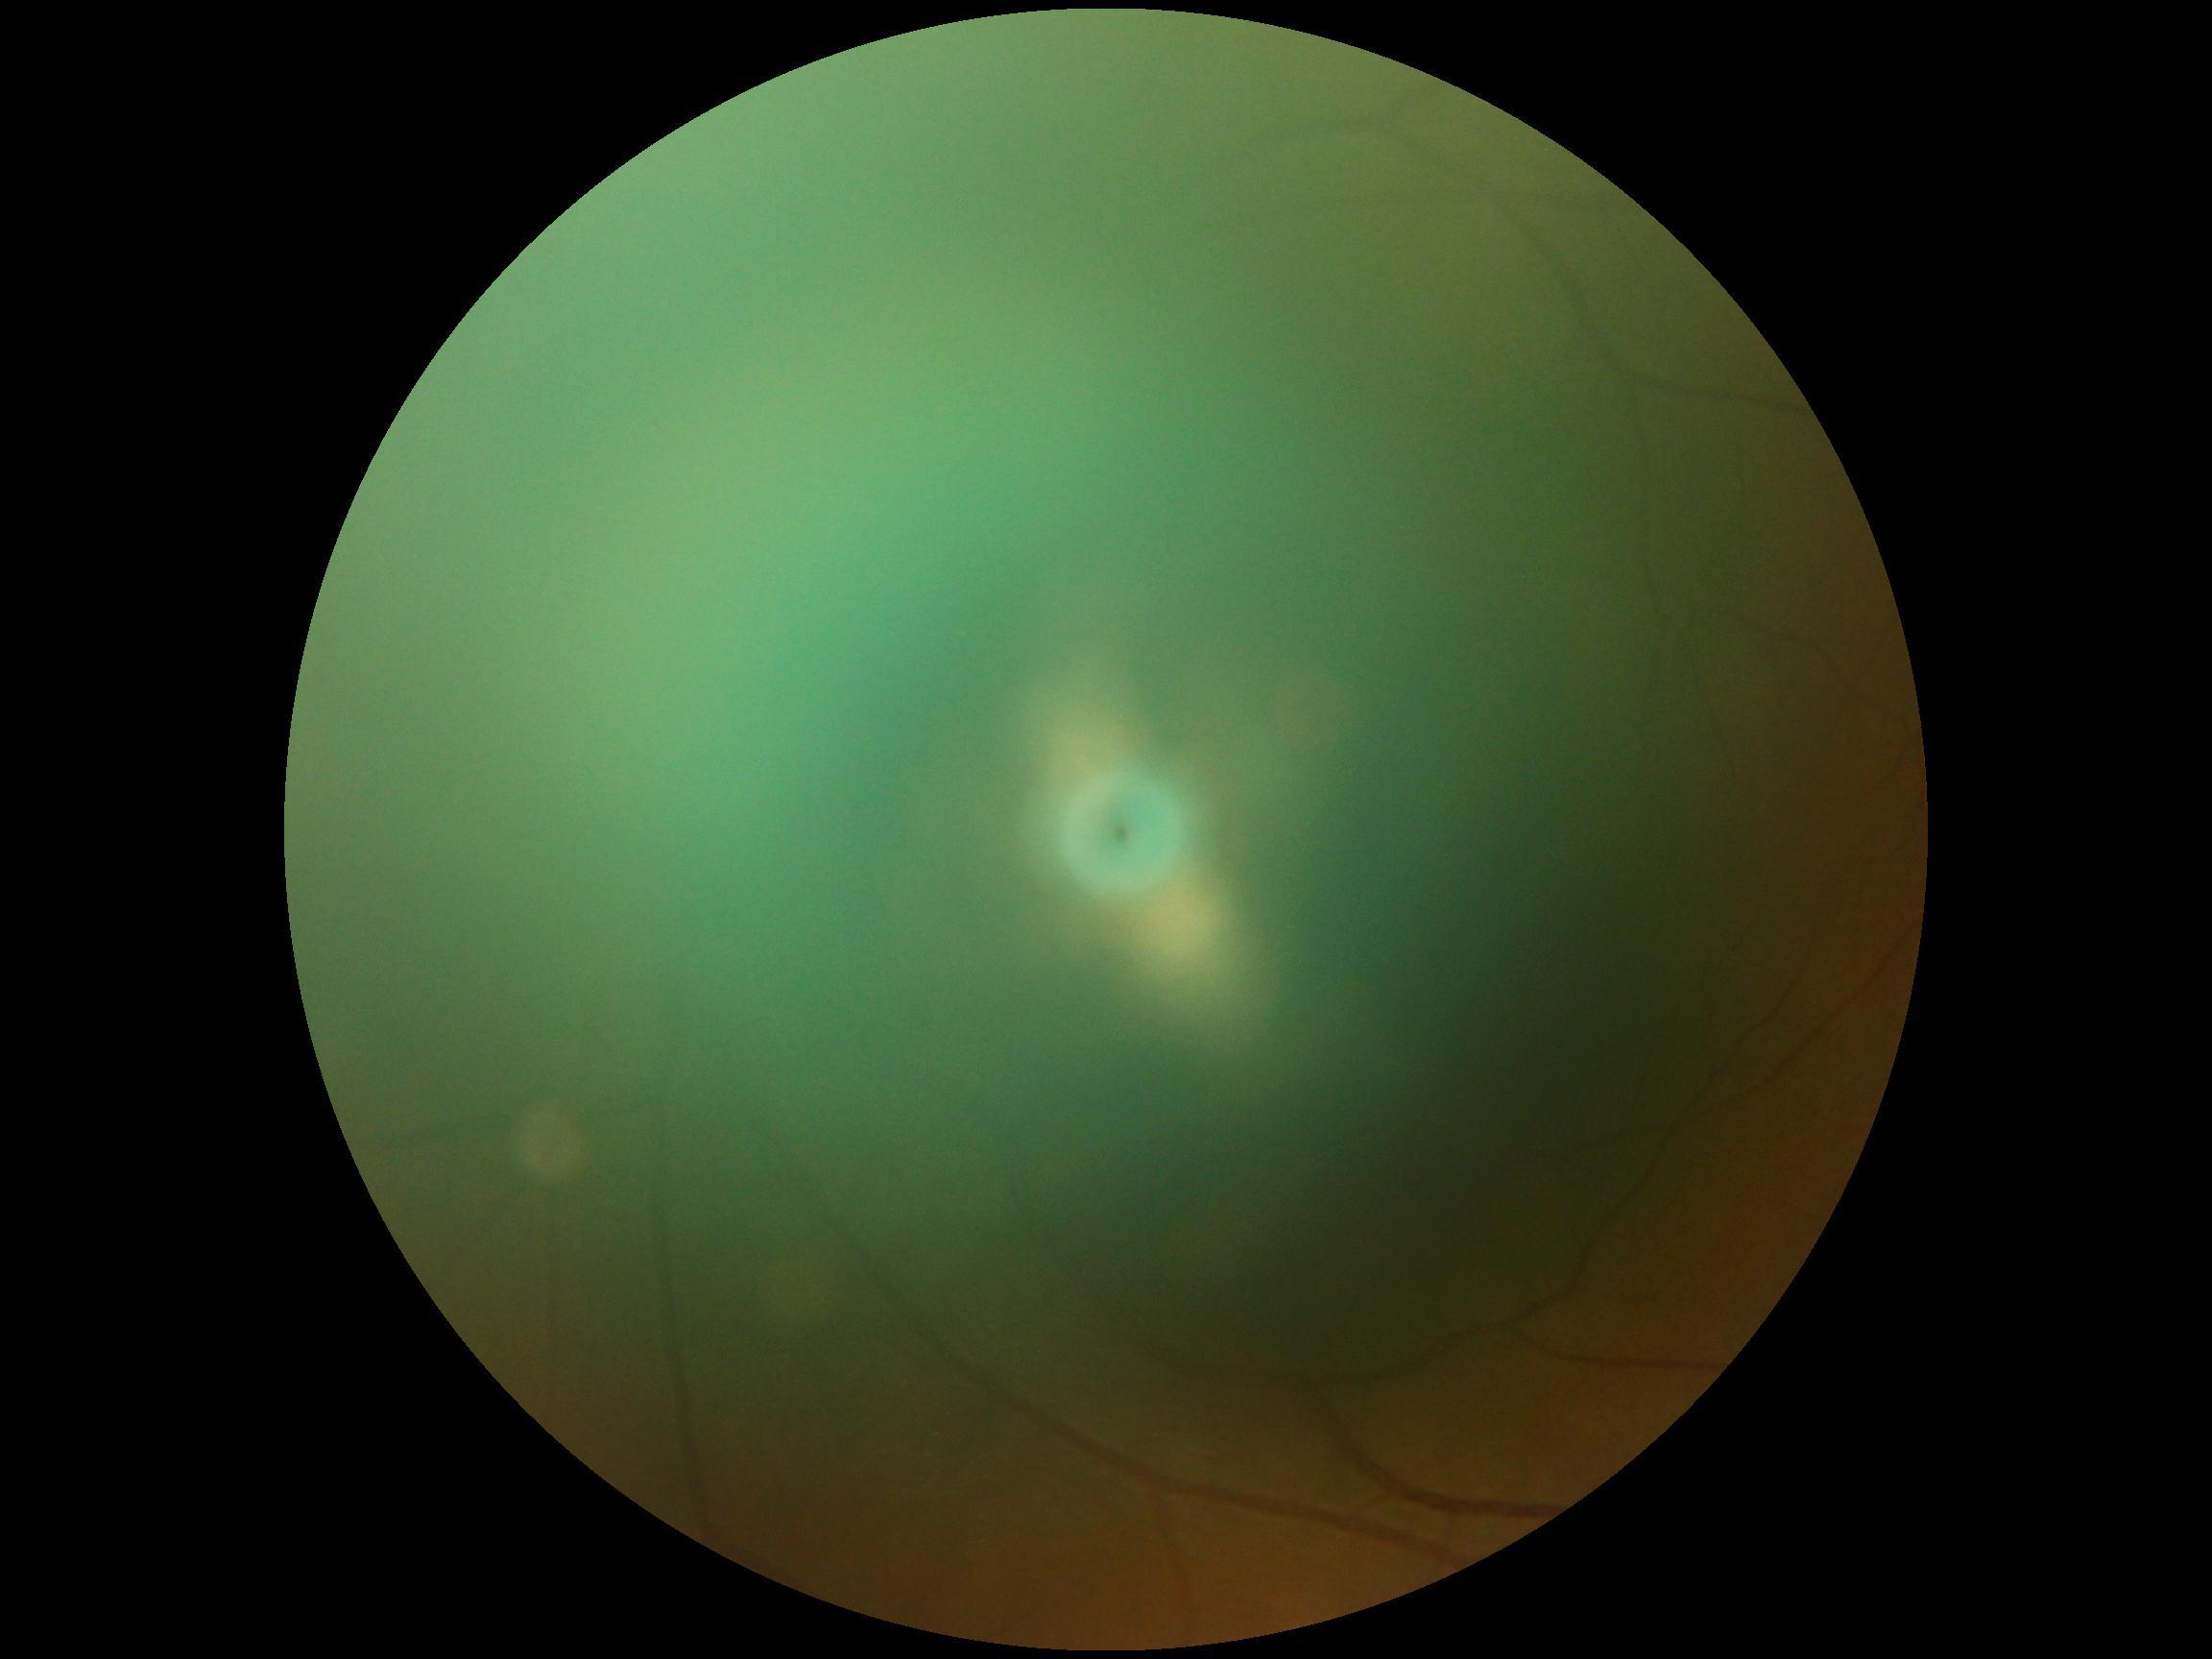
Diabetic retinopathy (DR): ungradable due to poor image quality.